45° FOV
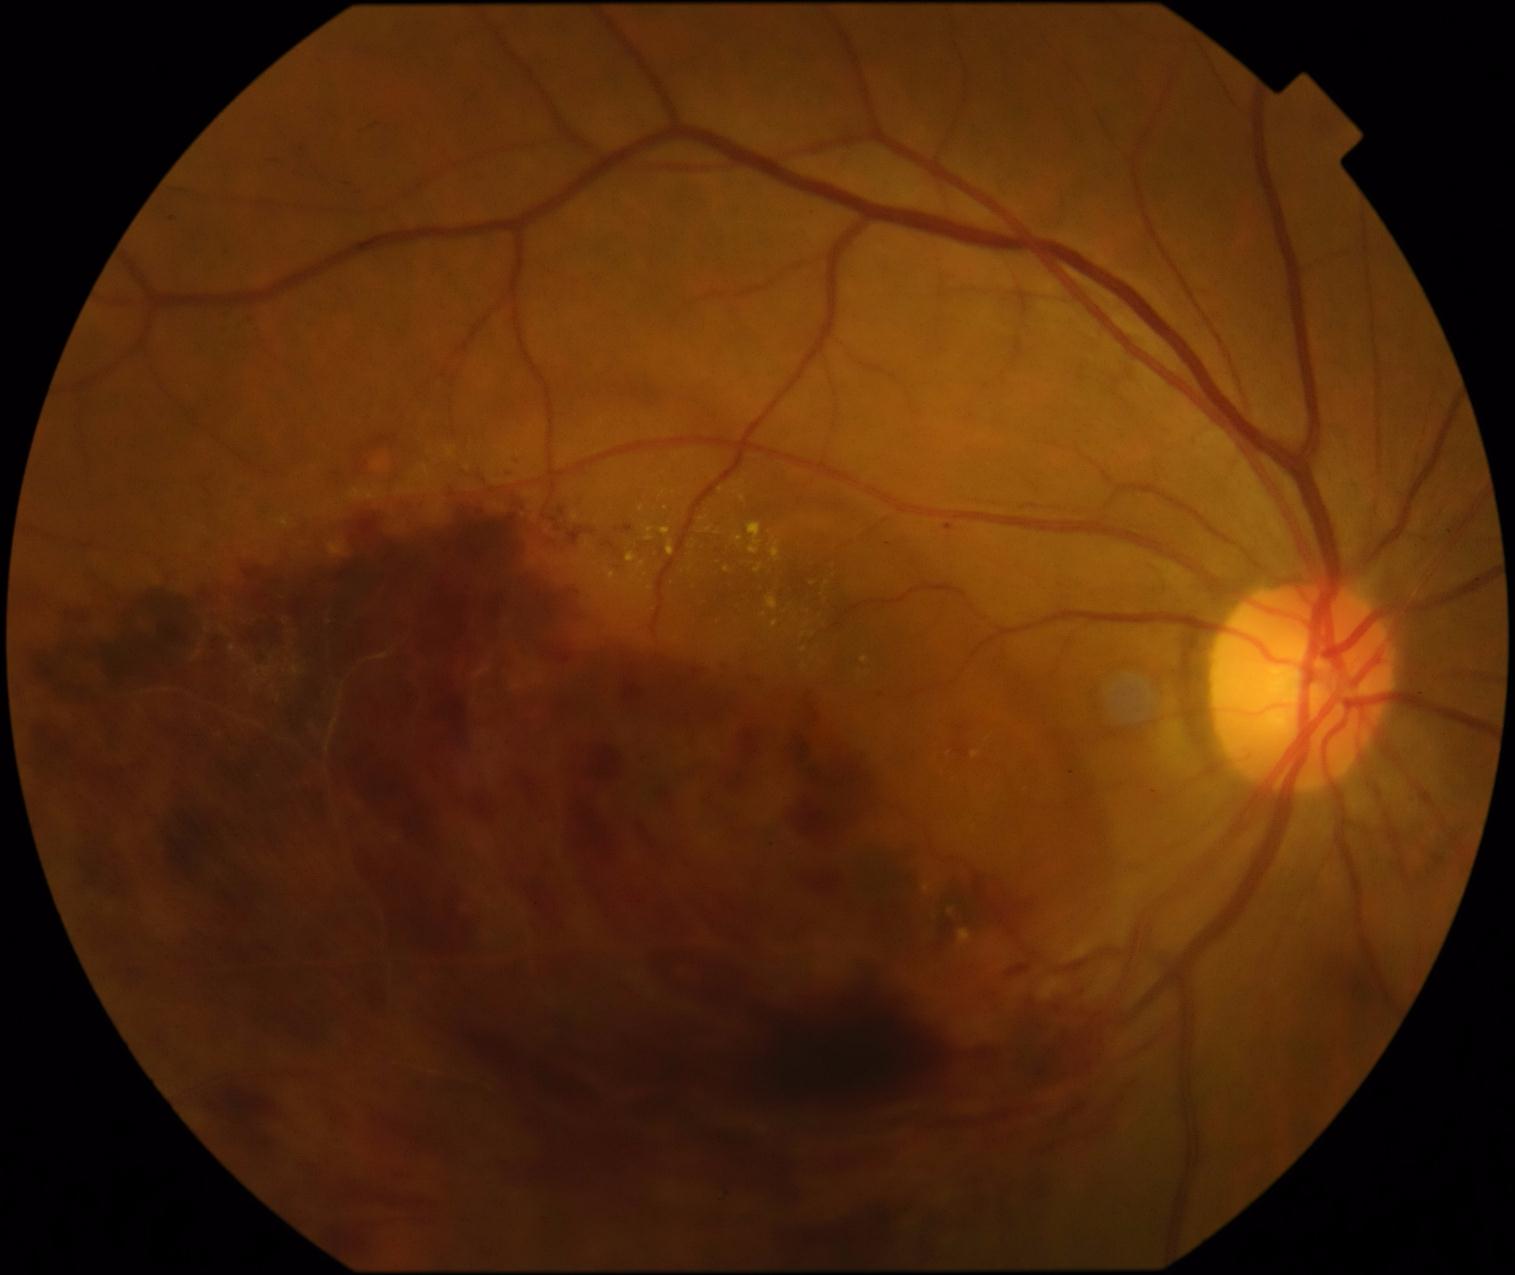 DR is PDR (grade 4) — neovascularization and/or vitreous/pre-retinal hemorrhage.
Disease class: proliferative diabetic retinopathy.